Ultra-widefield fundus photograph · 200-degree field of view:
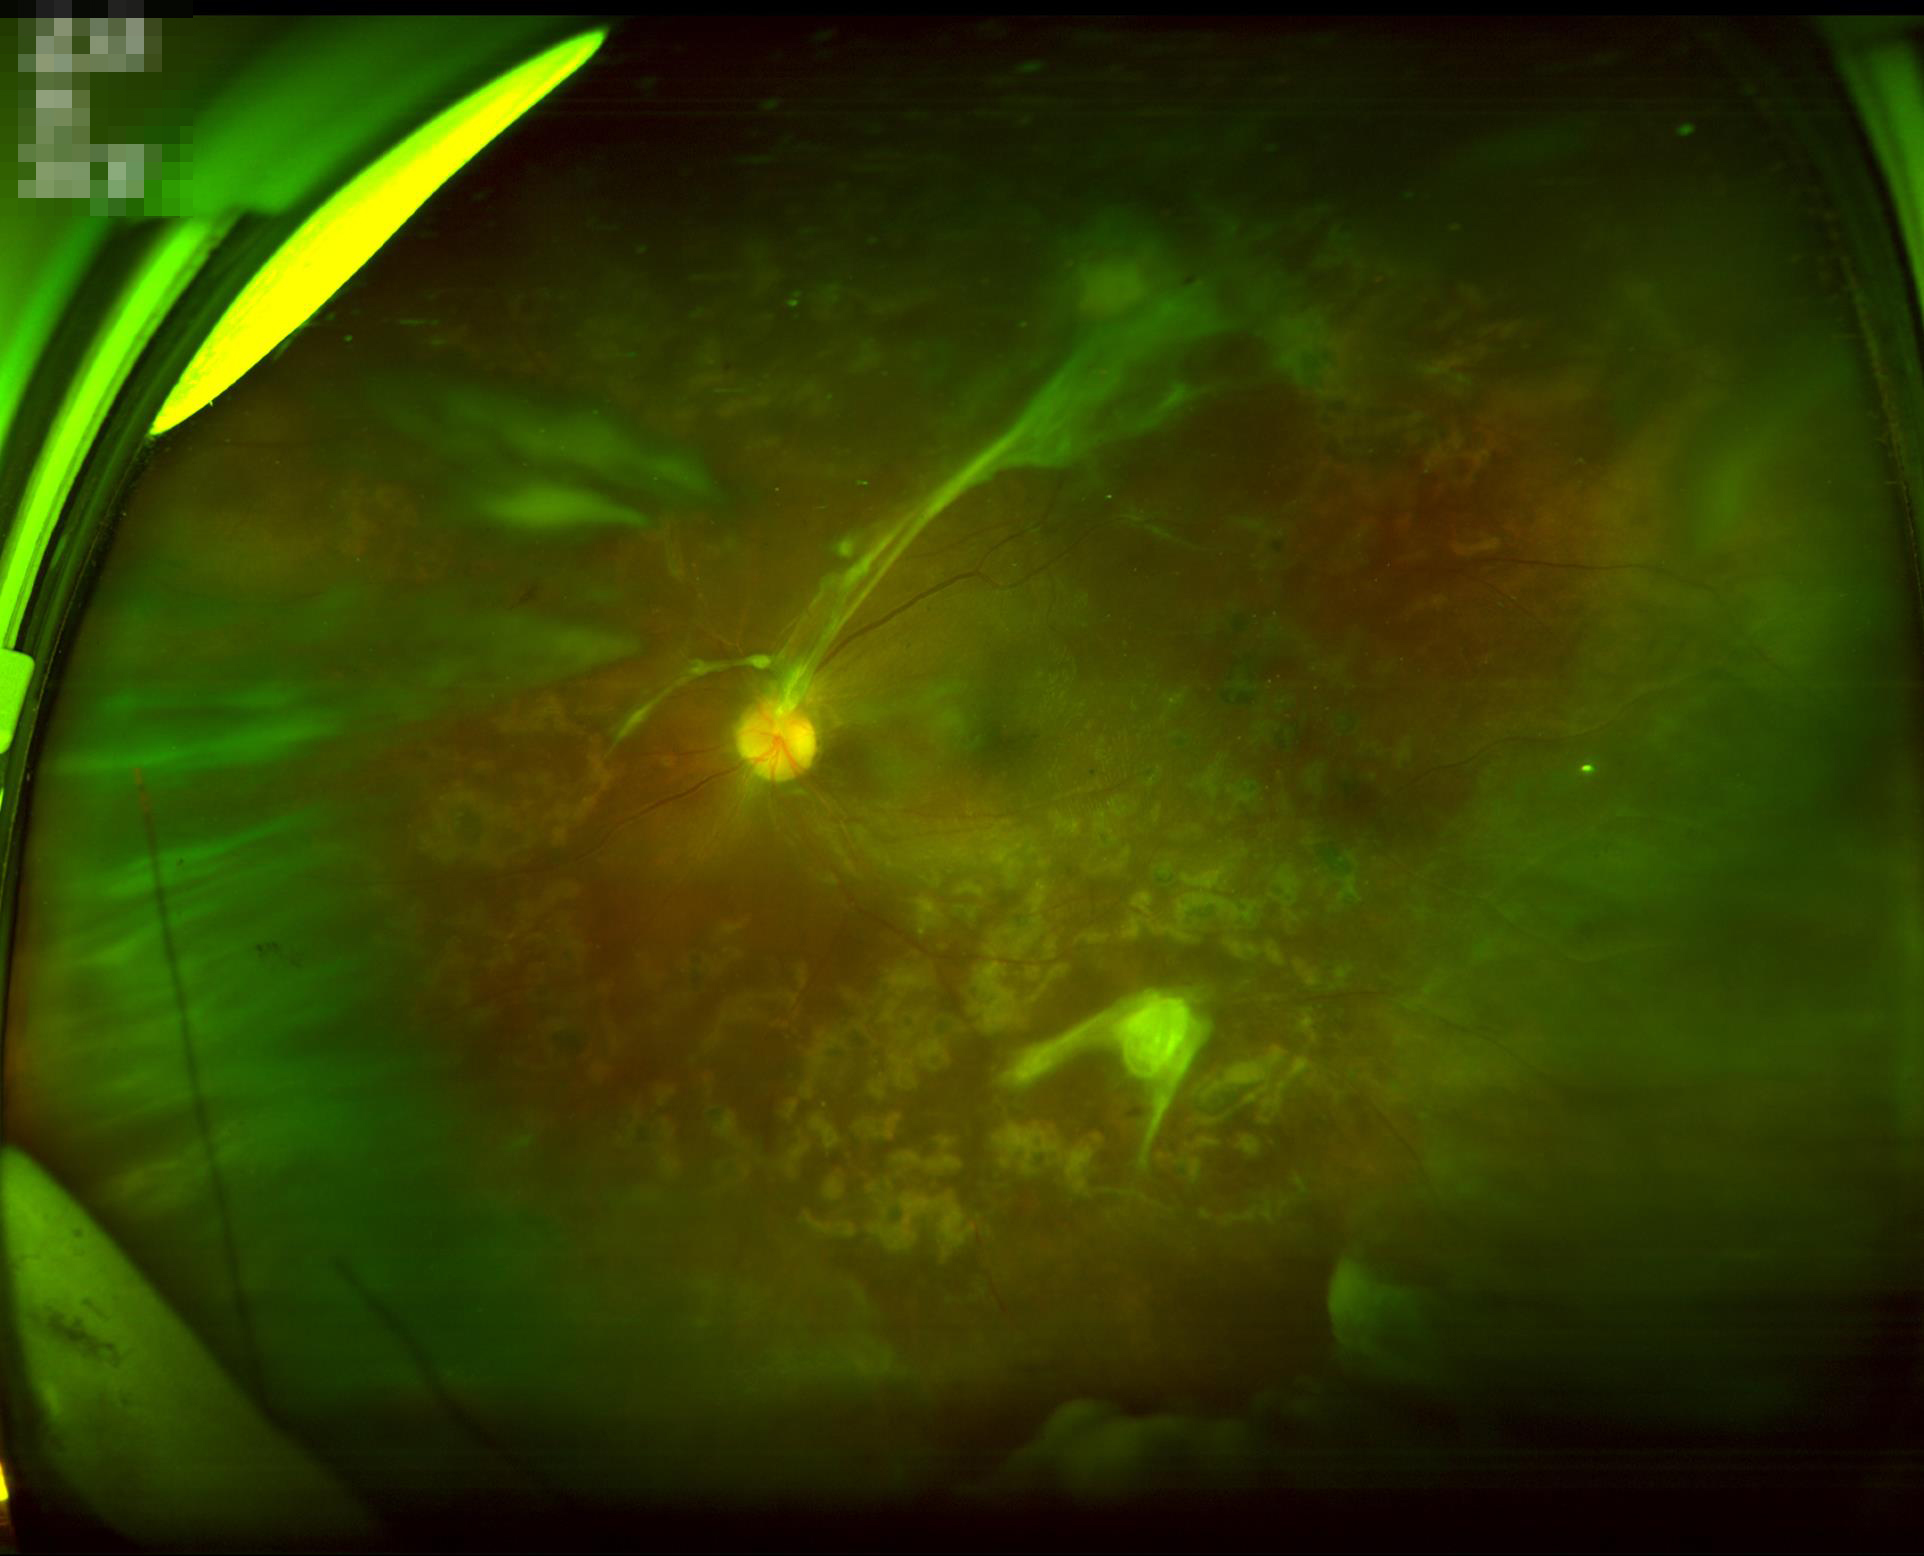 Image quality: illumination: suboptimal | clarity: out of focus | contrast: adequate | overall: suboptimal.